1659x2212px: 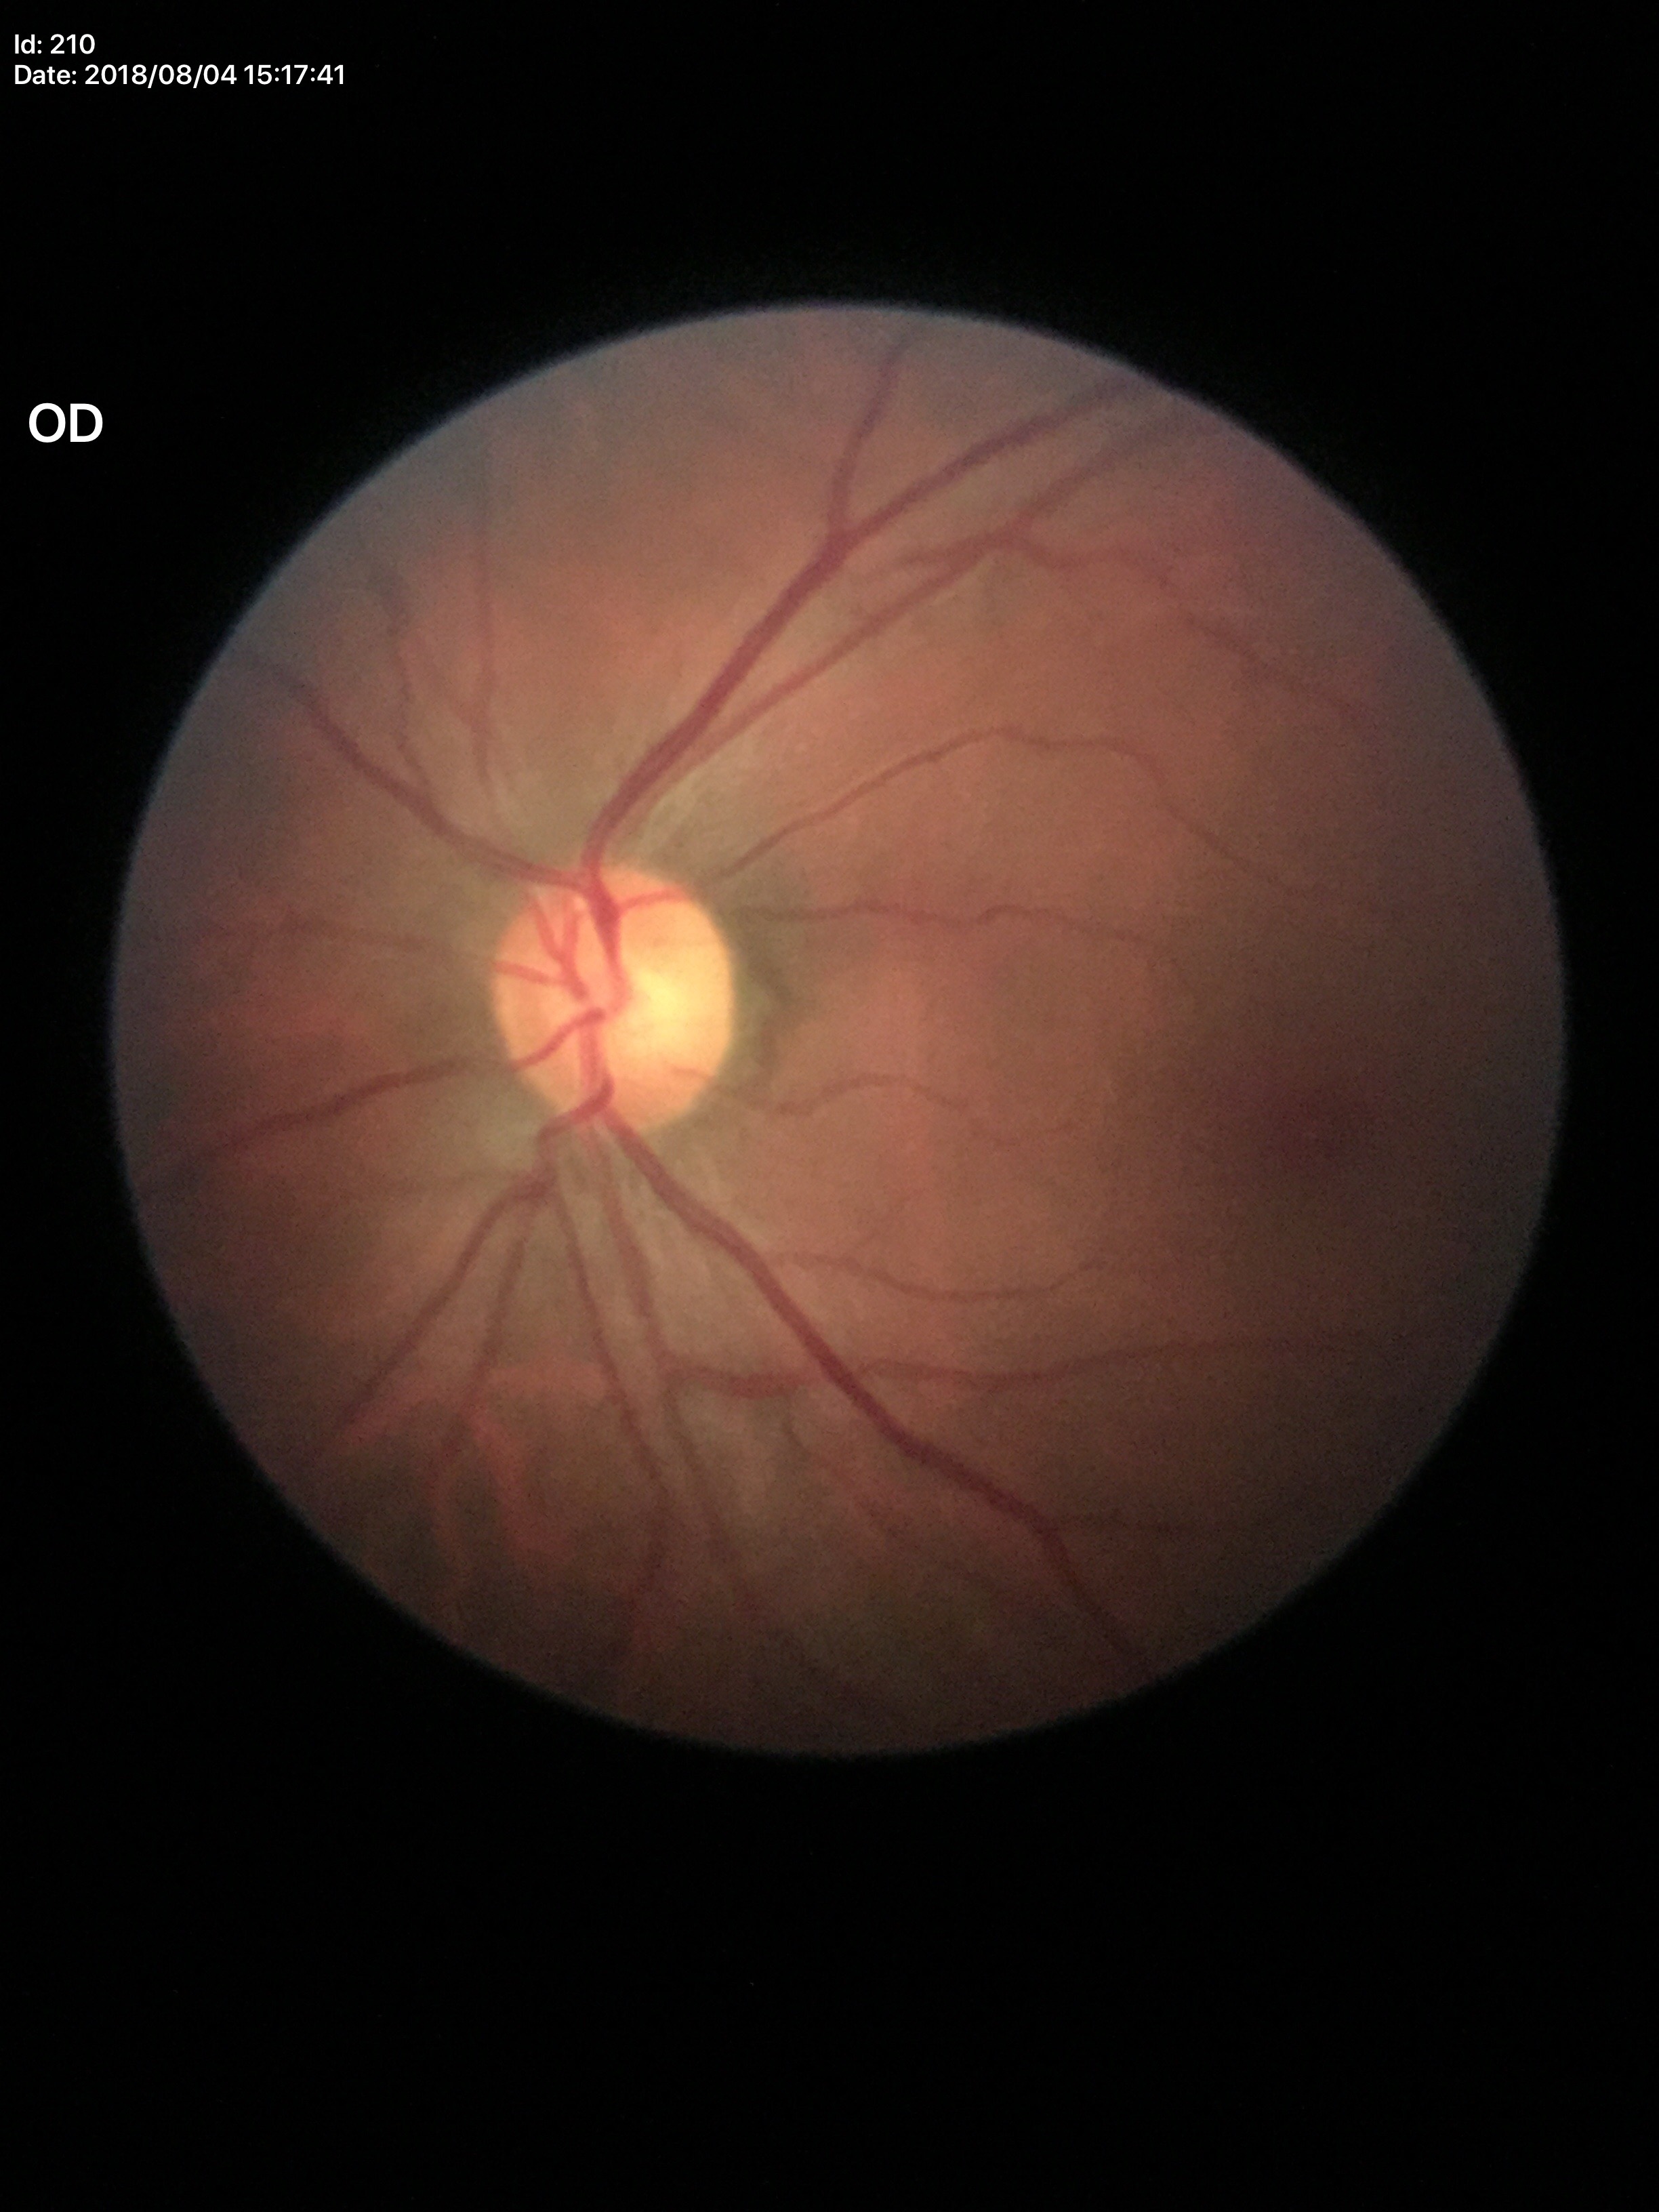

horizontal C/D ratio: 0.58, vertical CDR: 0.55, Glaucoma screening: not suspect.